Retinal fundus photograph; 2352x1568: 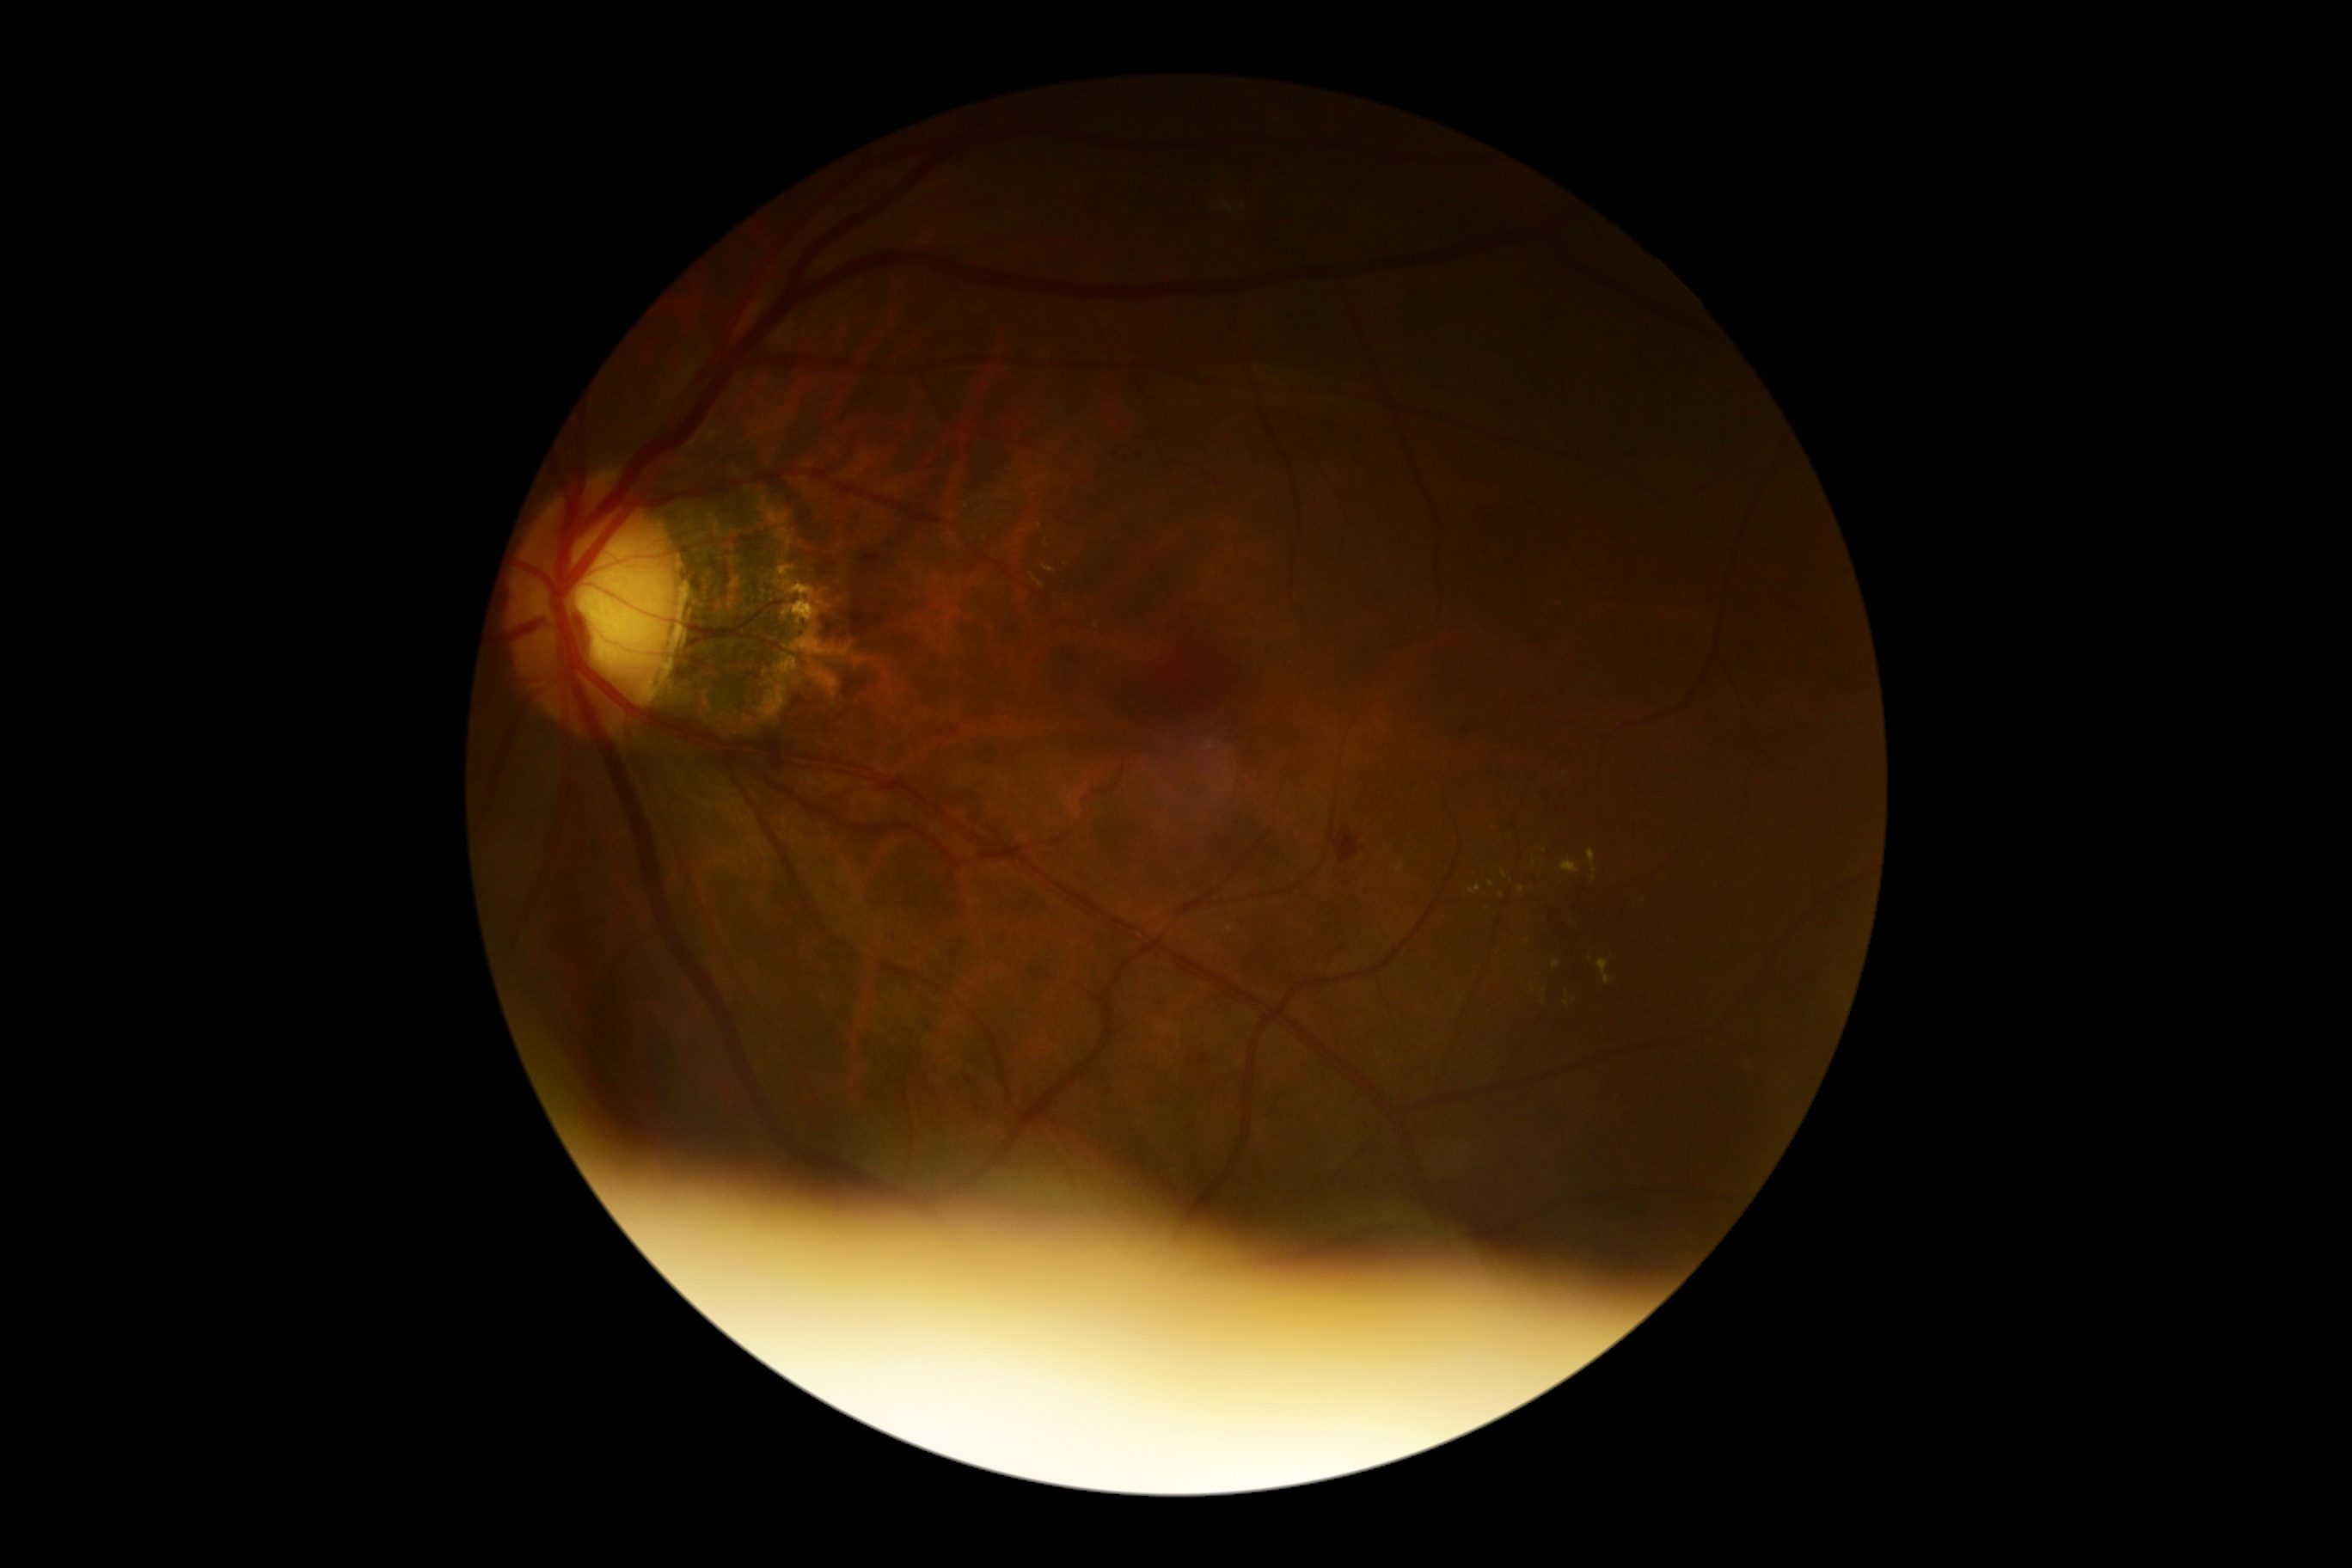
Disease class: non-proliferative diabetic retinopathy. DR is moderate non-proliferative diabetic retinopathy (grade 2).